1932 by 1916 pixels — 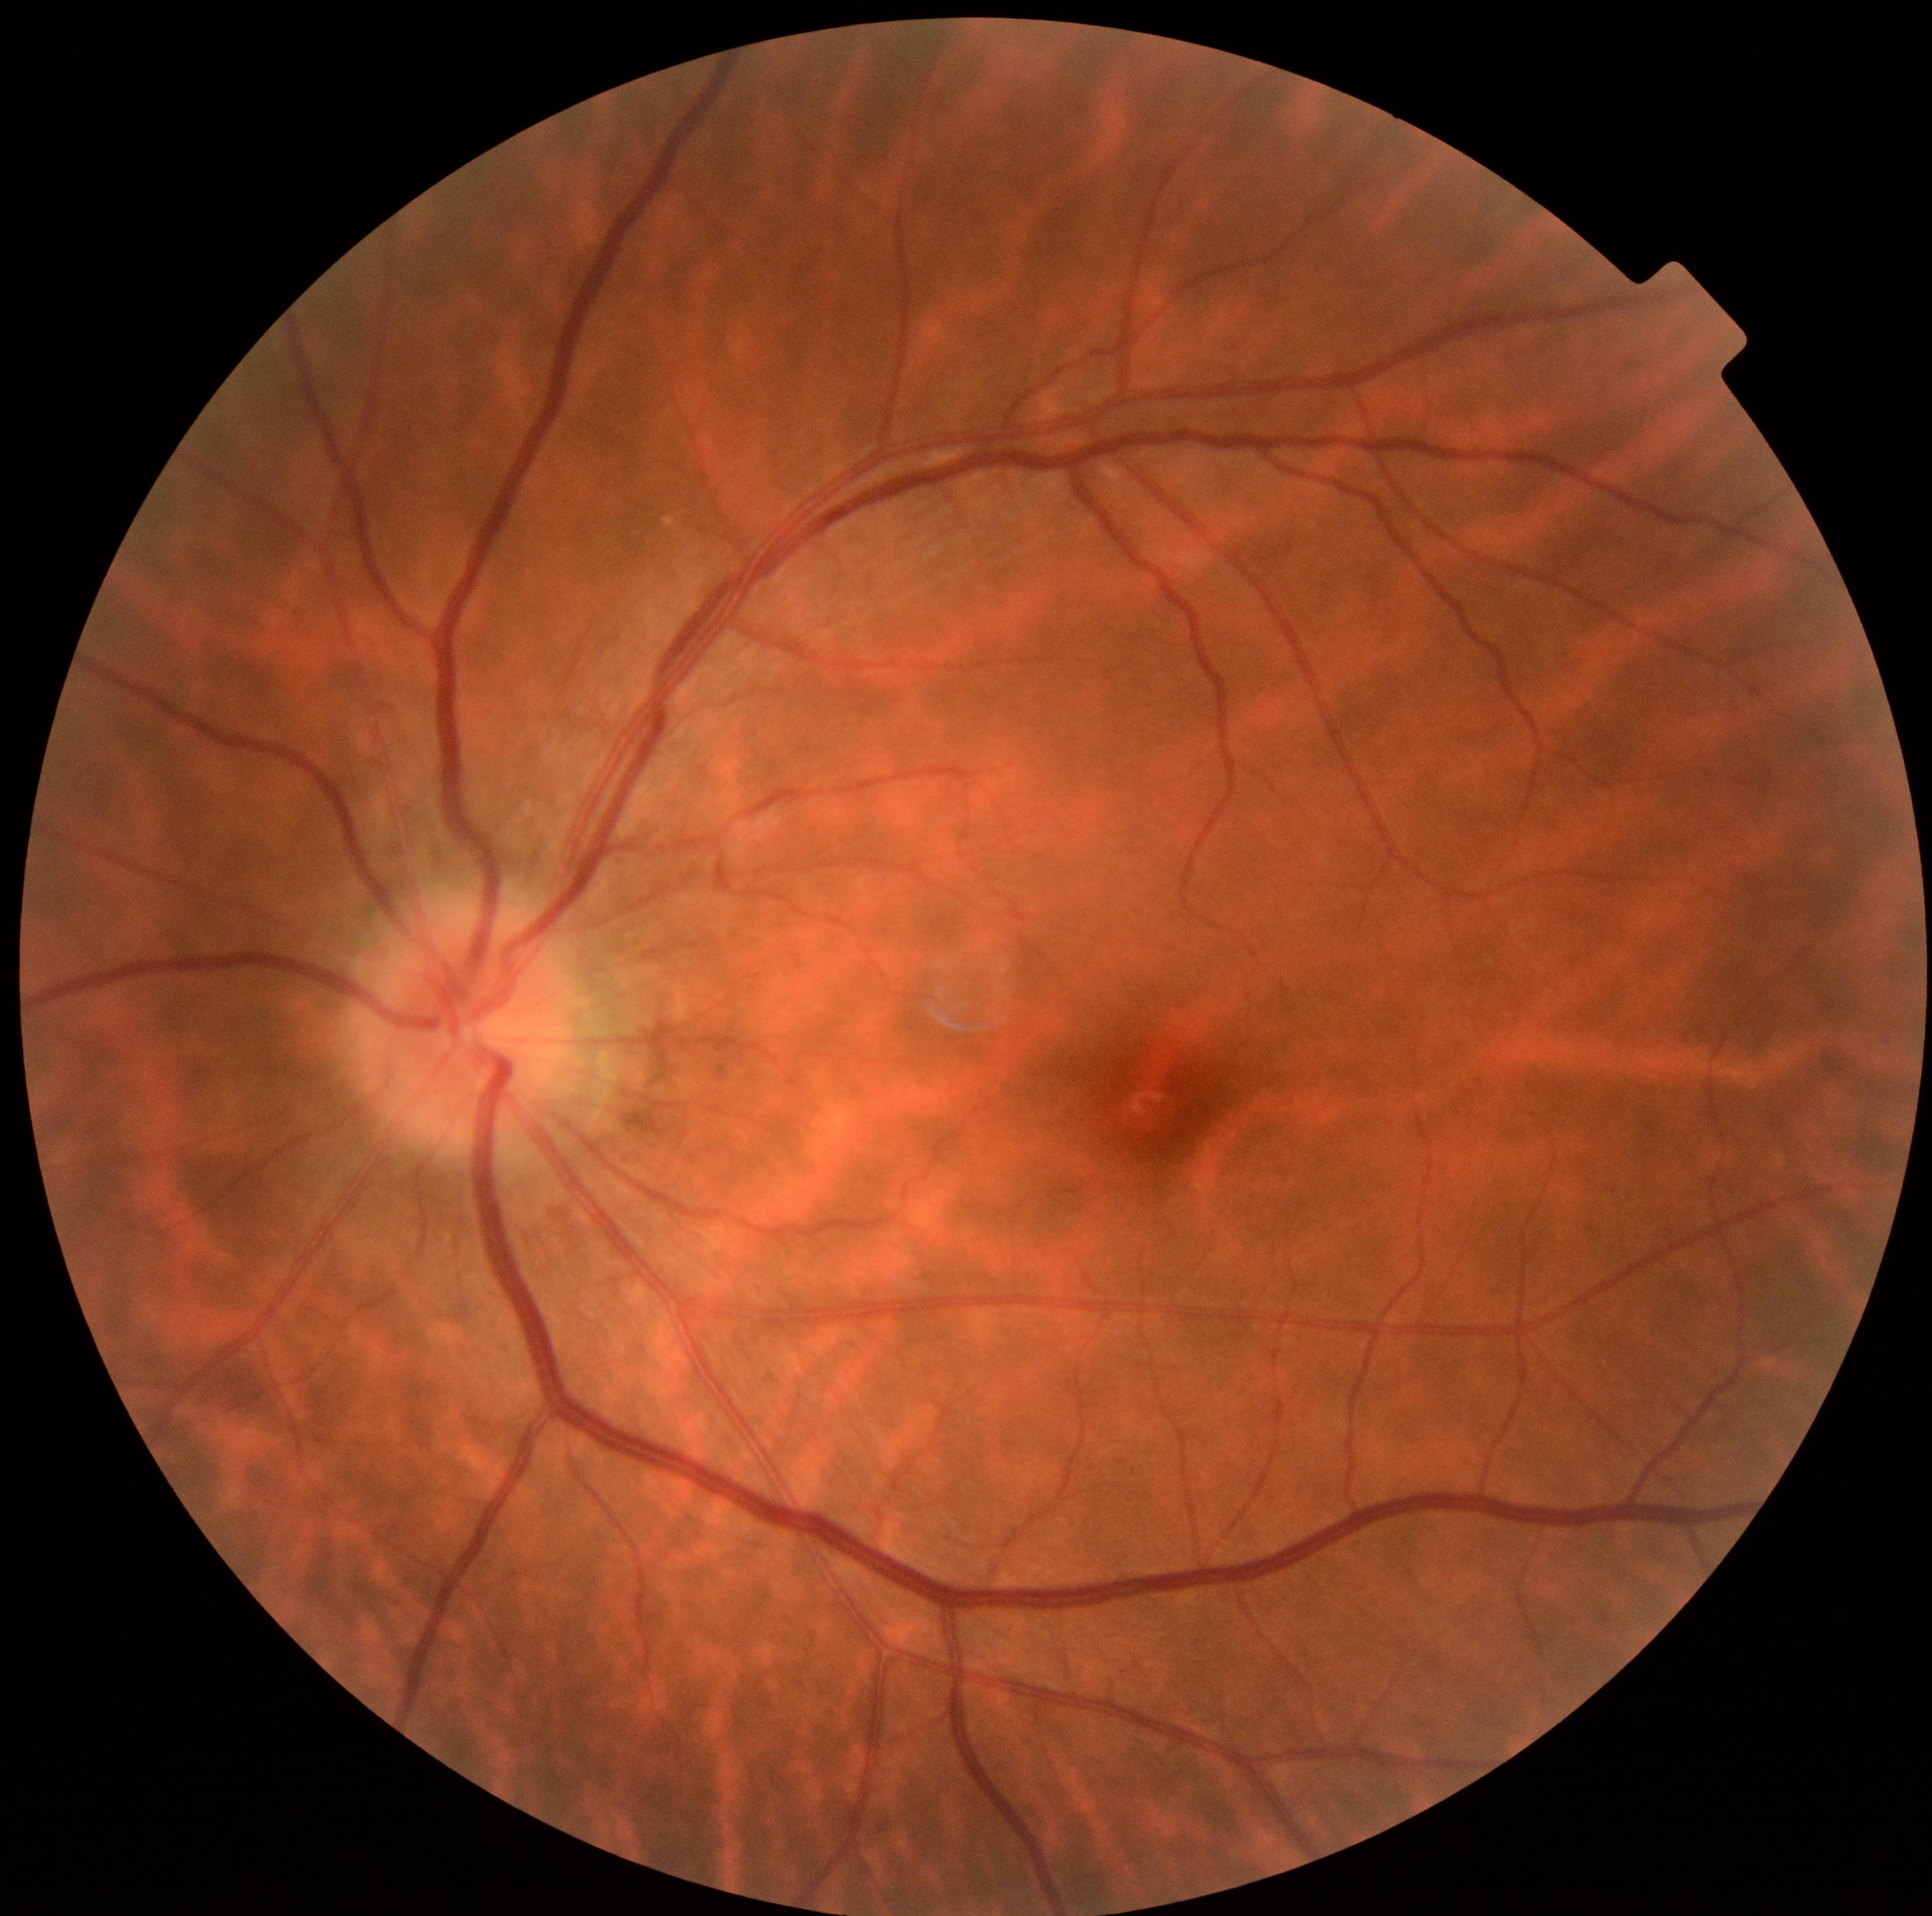

{"dr_impression": "no apparent DR", "dr_grade": "0/4"}